45° FOV · color fundus photograph:
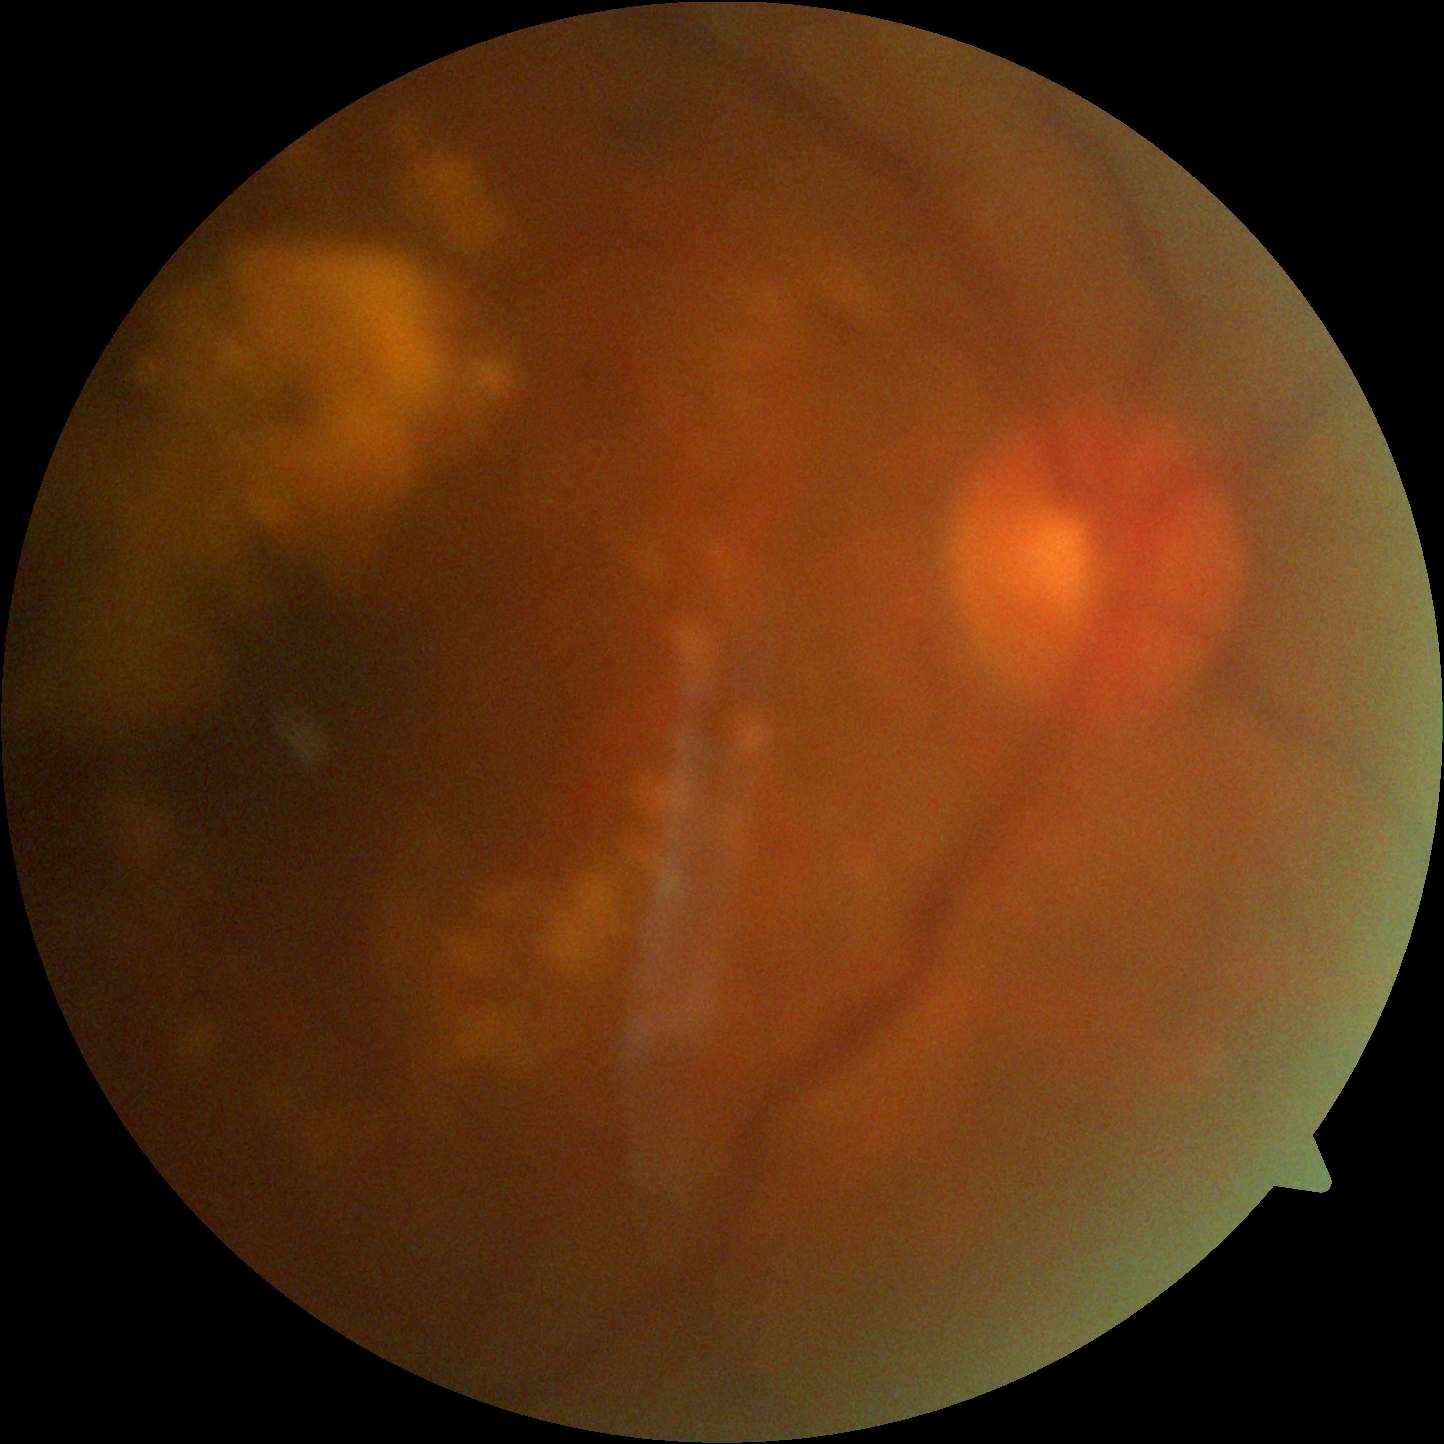
Image quality is insufficient for diabetic retinopathy assessment. DR grade is ungradable due to poor image quality.